240 x 240 pixels, non-mydriatic:
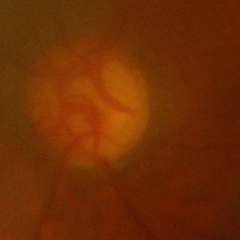
Advanced glaucomatous optic neuropathy.